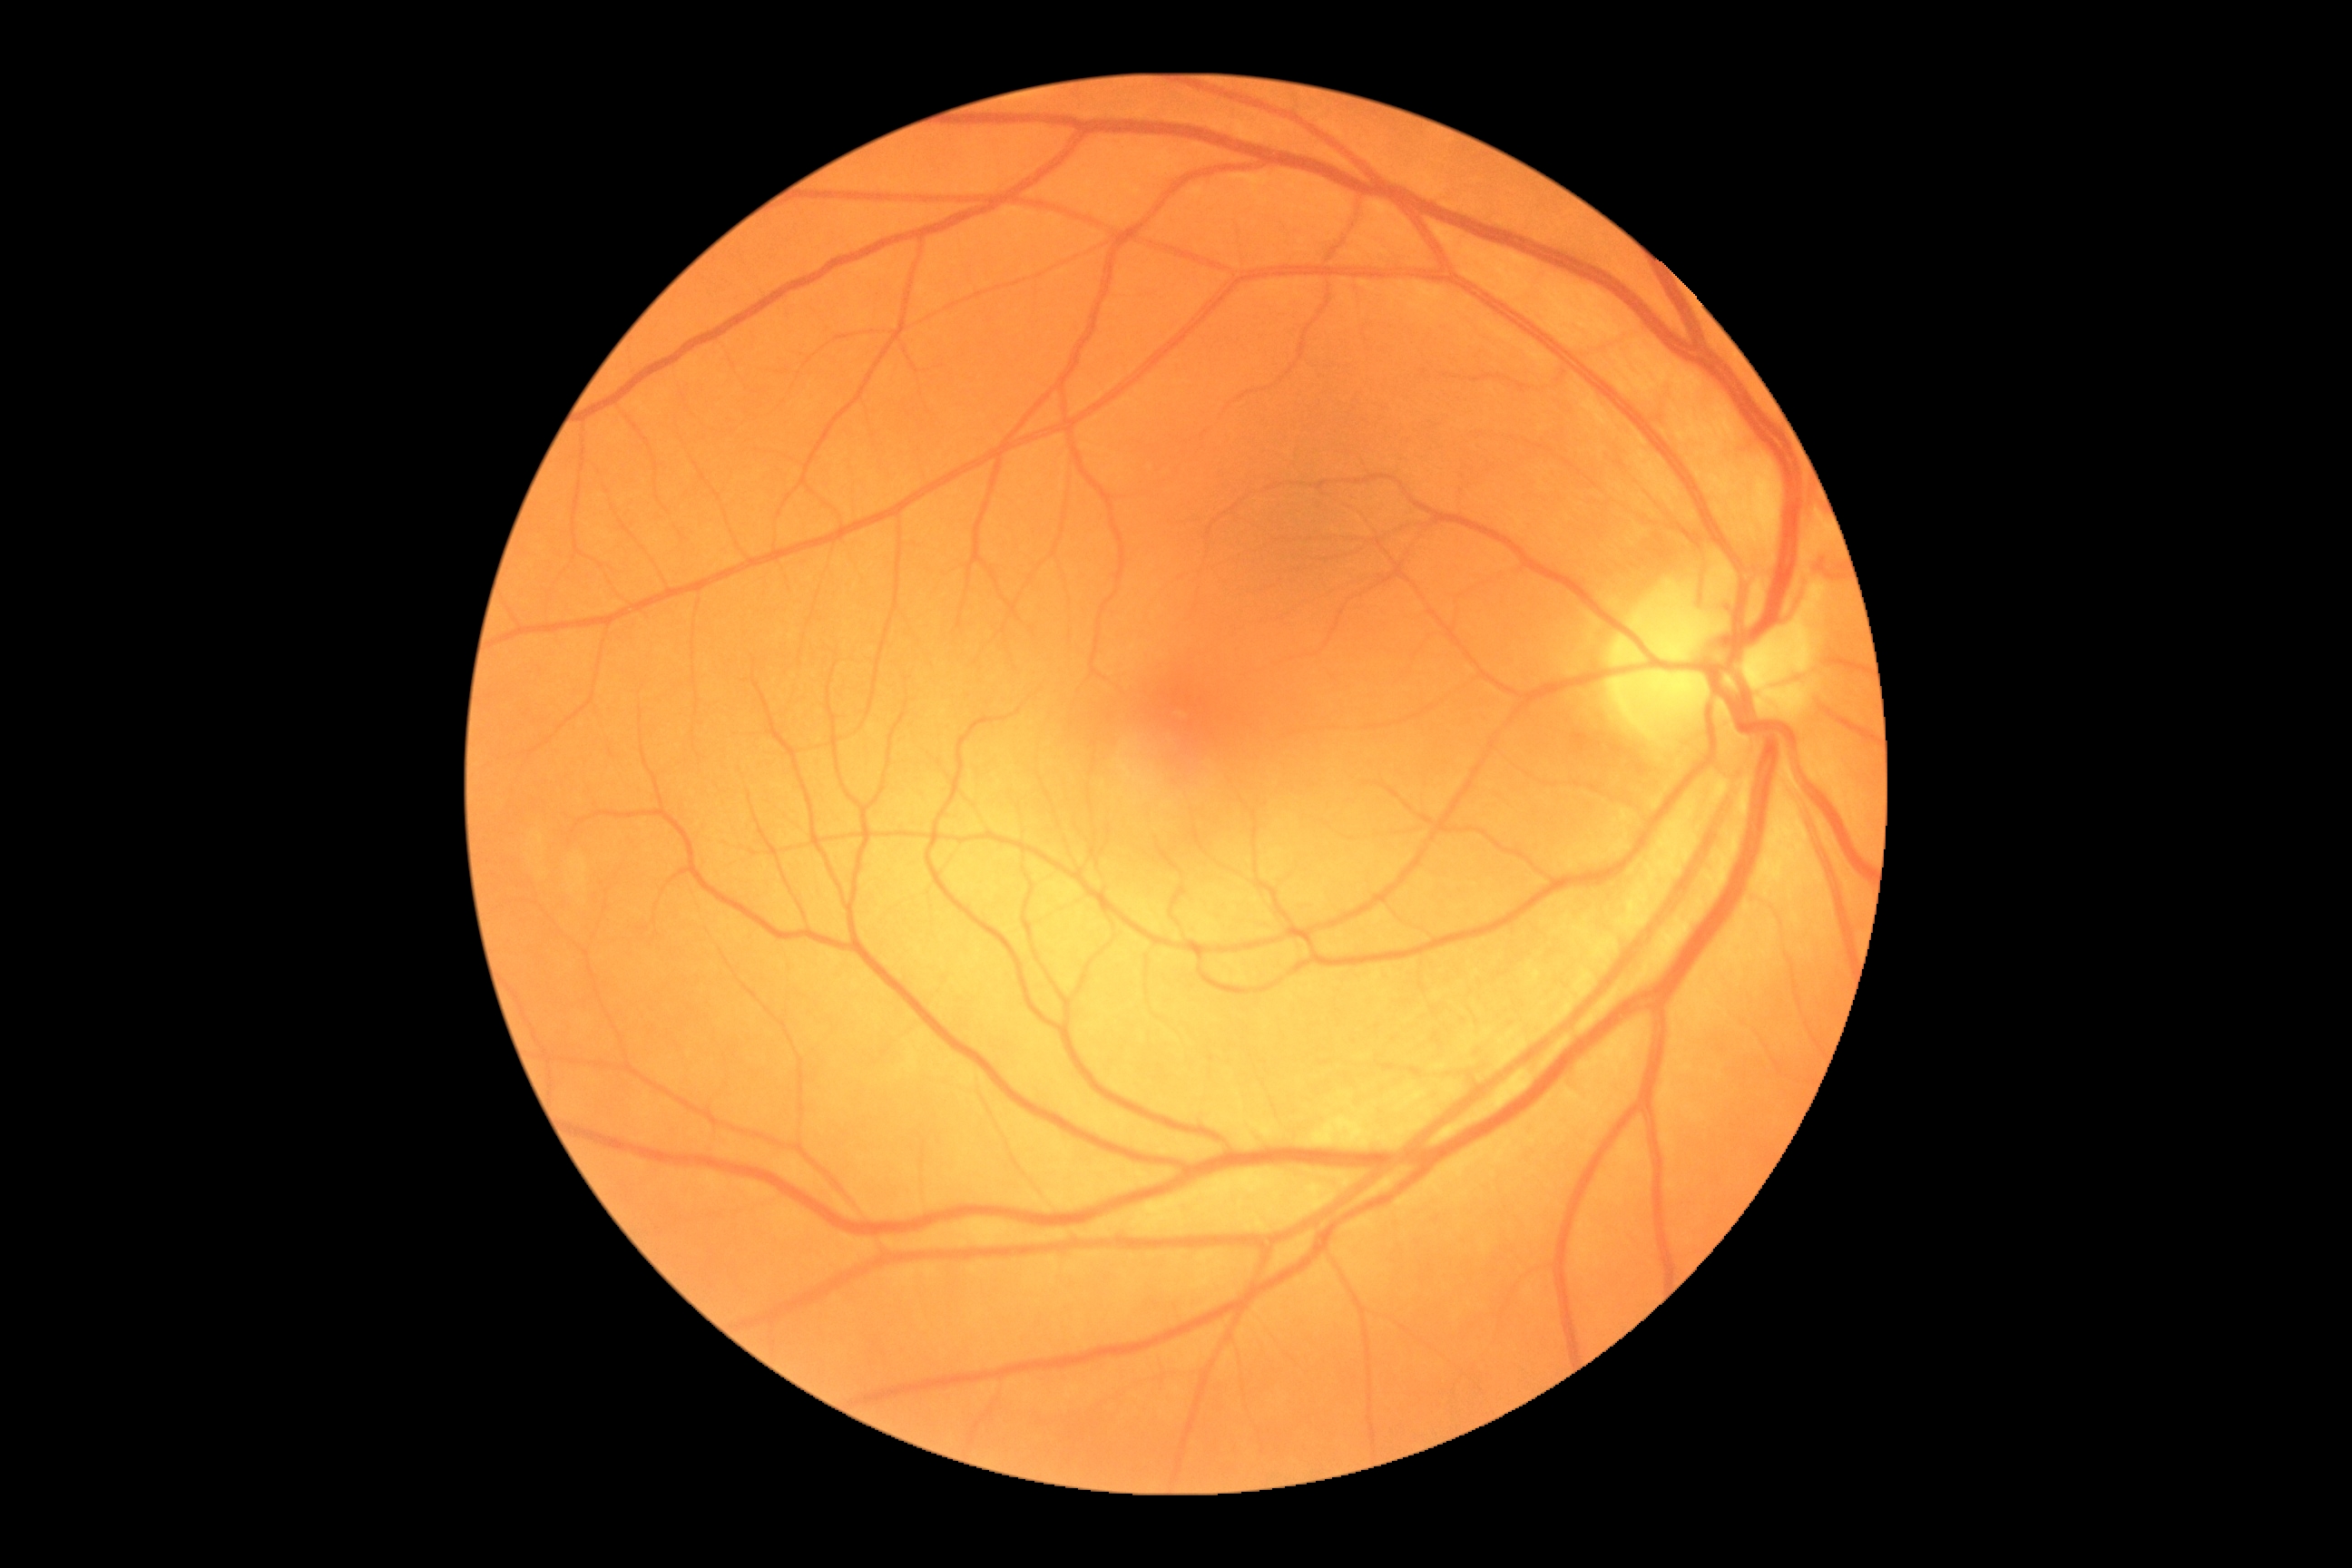 Diabetic retinopathy (DR) is 0/4.